Remidio Fundus on Phone (FOP) camera — 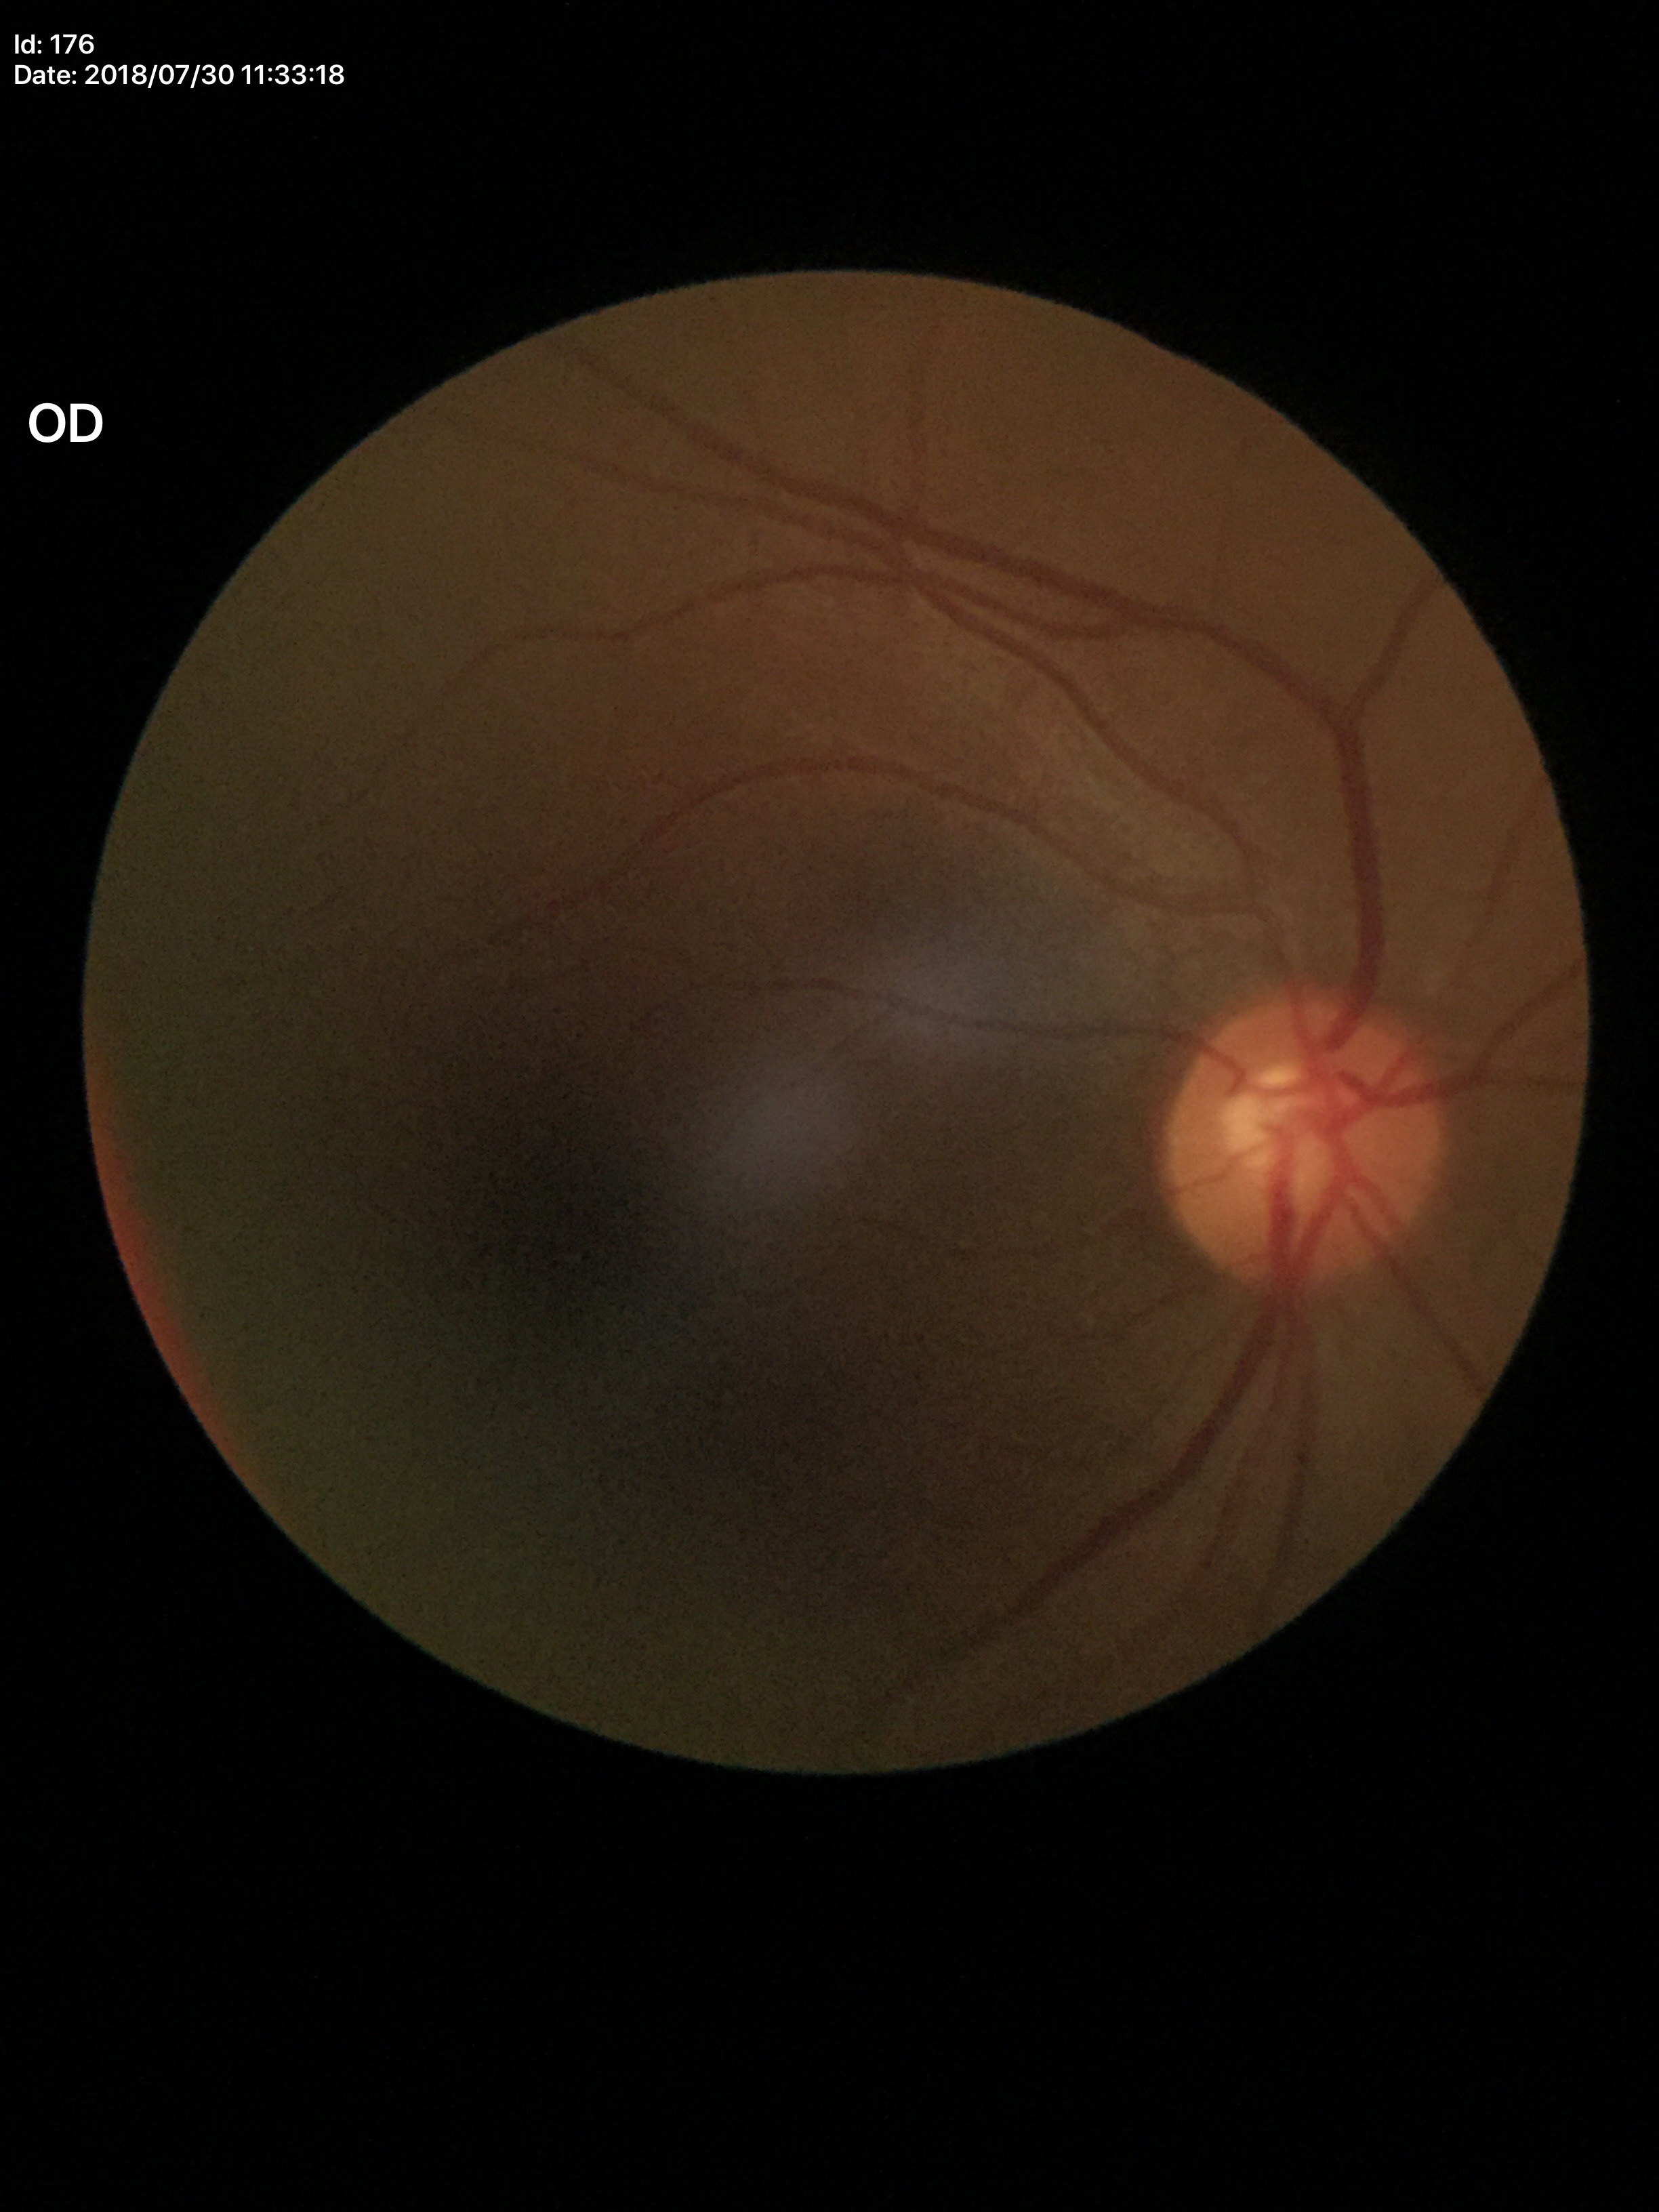

Glaucoma impression=negative (all 5 graders called normal); VCDR=0.52; ACDR=0.30